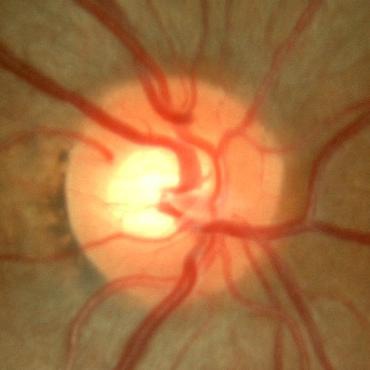

Optic disc appearance consistent with no evidence of glaucoma.